Color fundus photograph, camera: Bosch handheld camera:
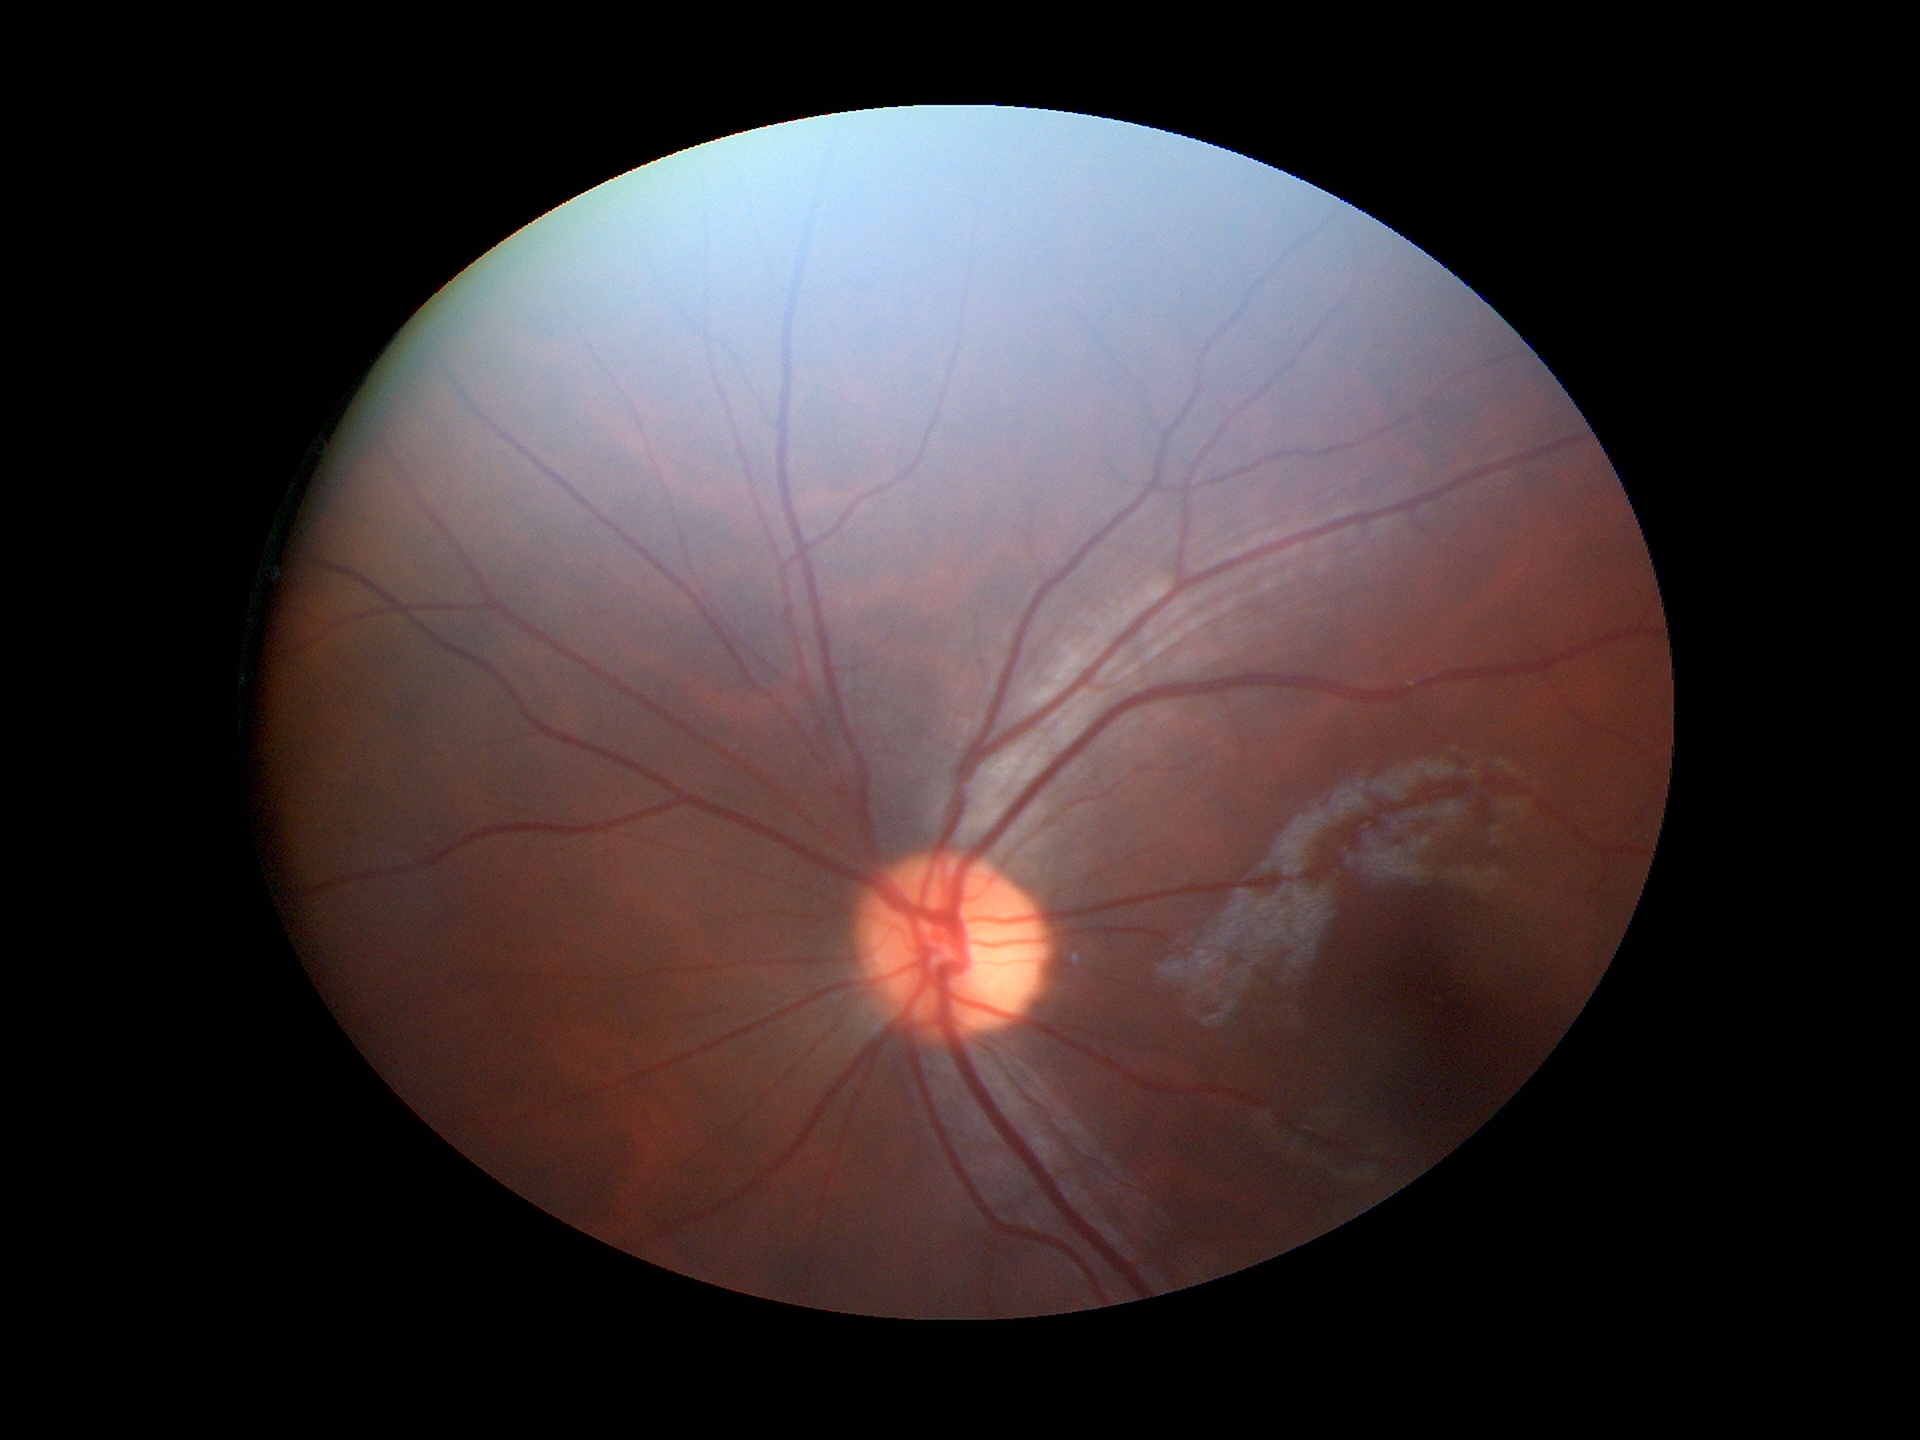
Horizontal CDR is 0.45. Glaucoma impression: negative. Vertical cup-to-disc ratio is 0.46.